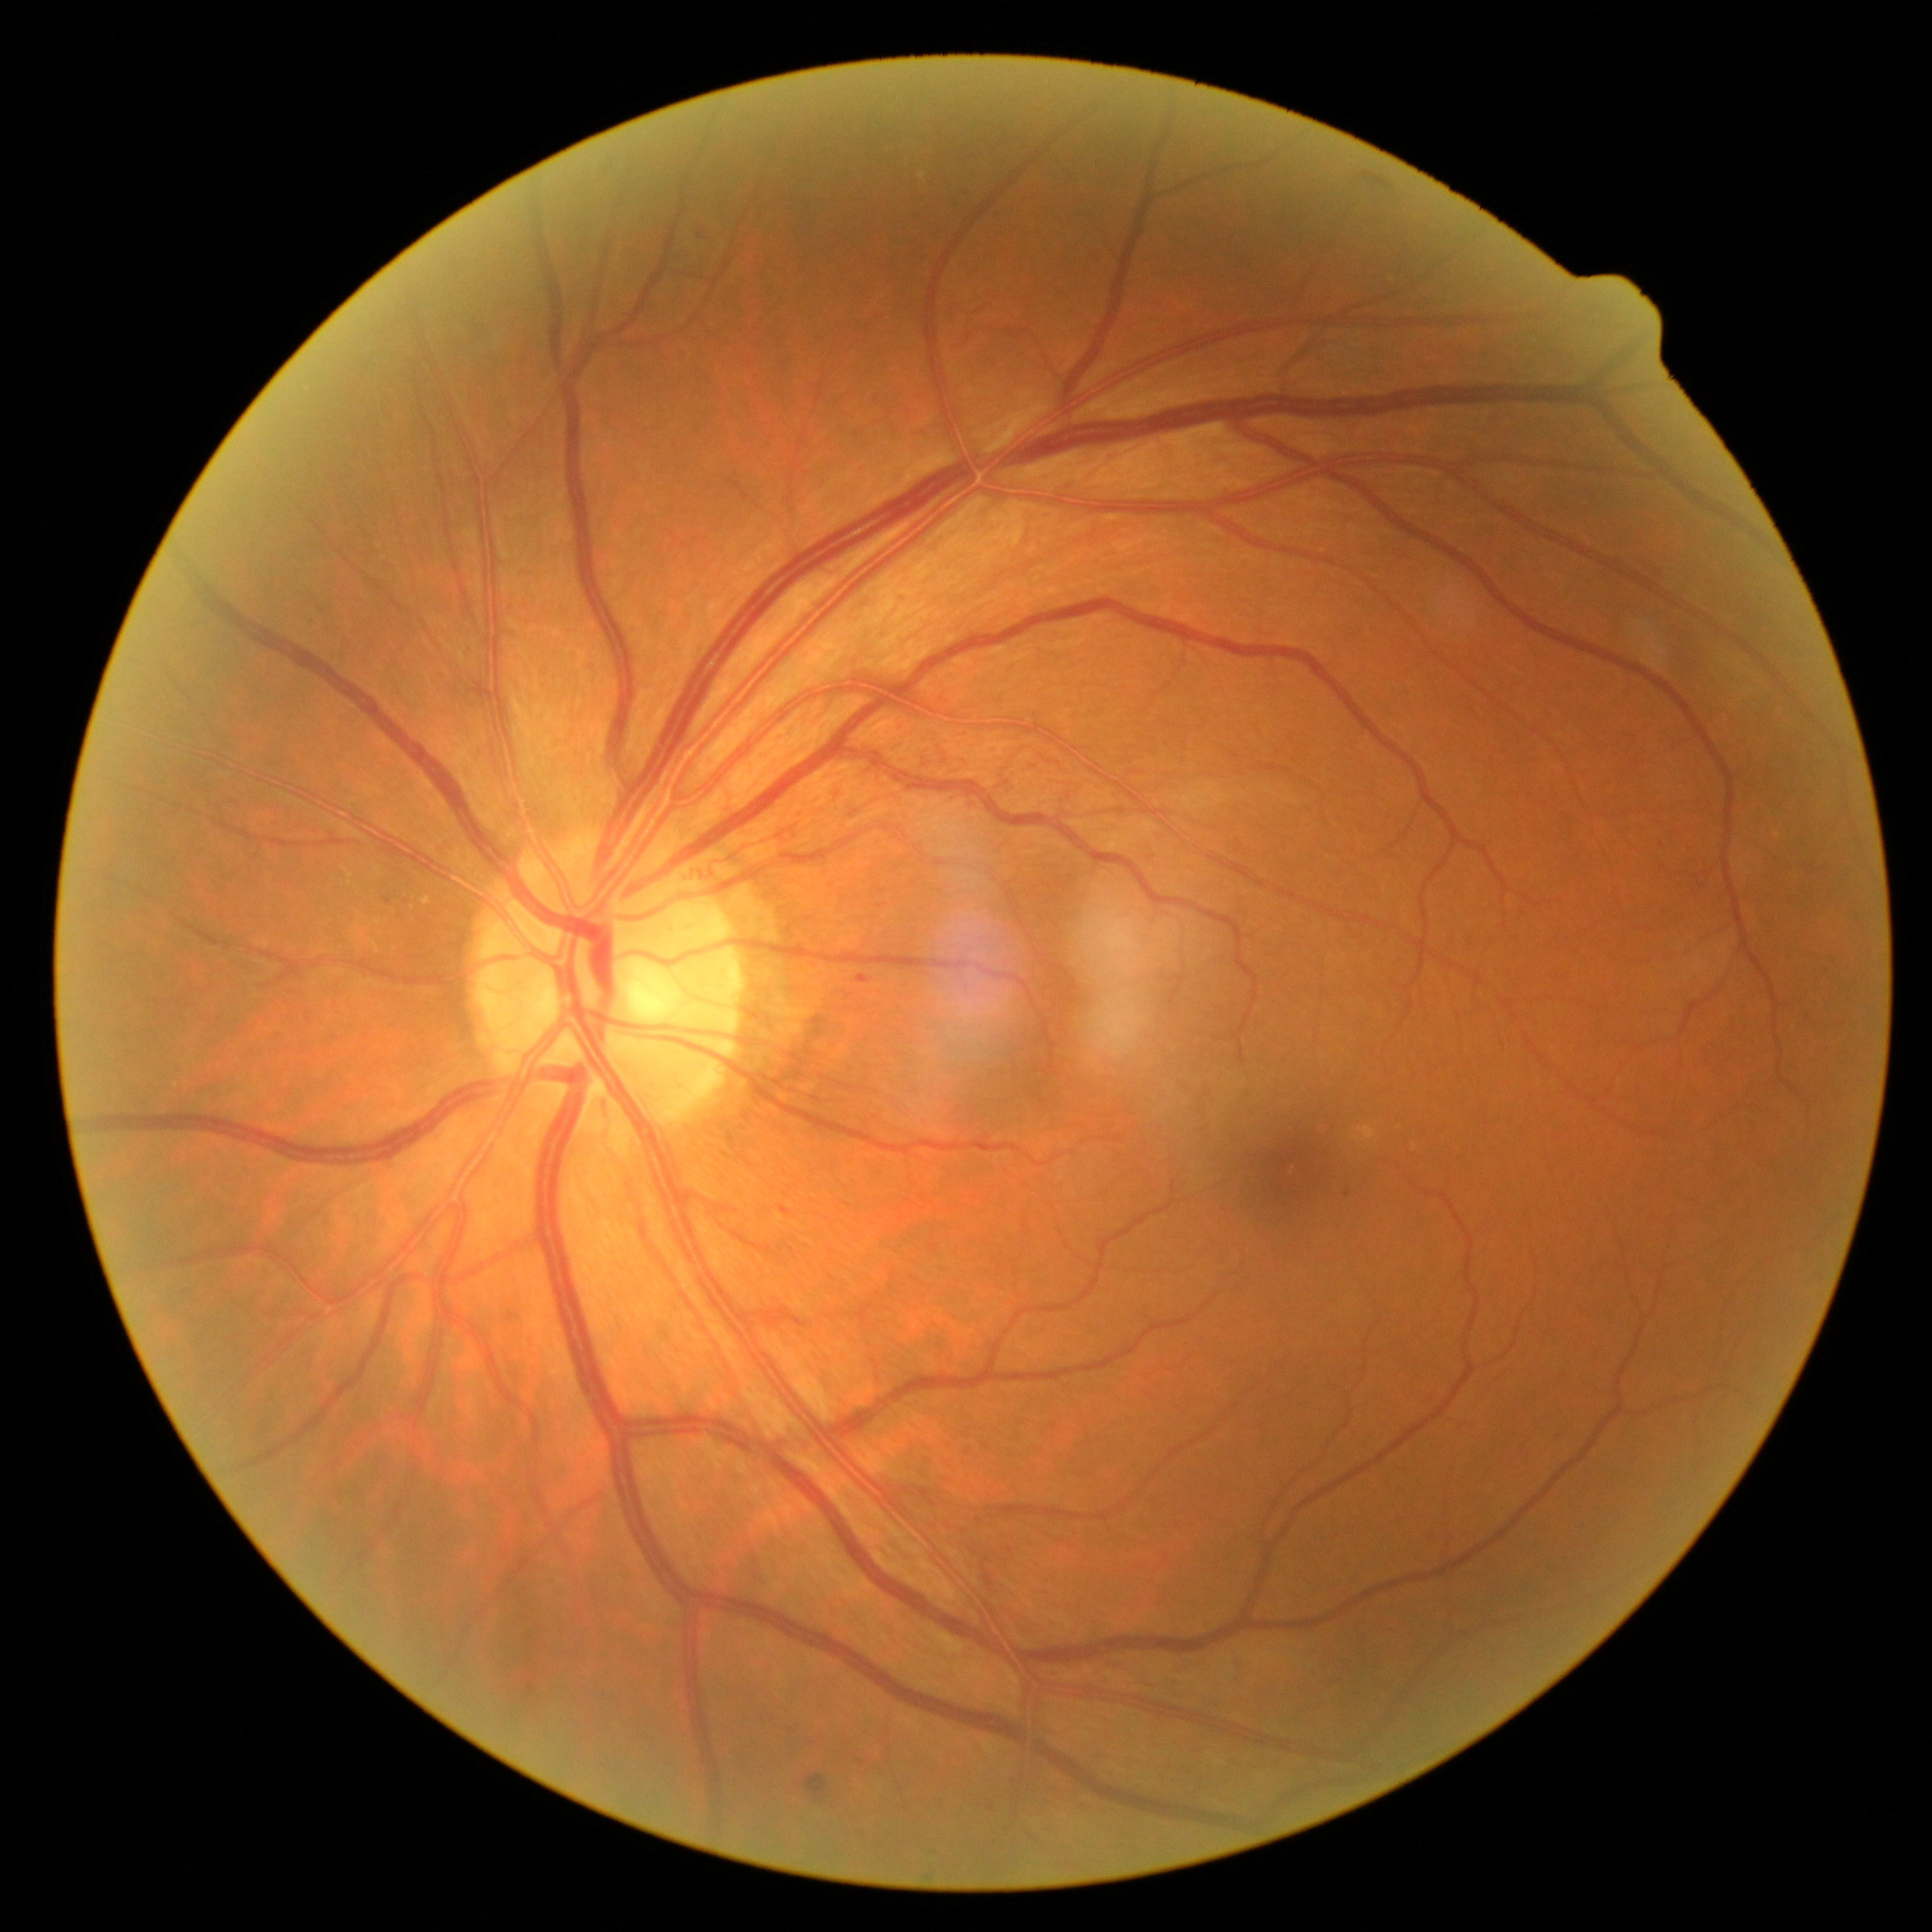

diabetic retinopathy = grade 2 (moderate NPDR)
DR class = non-proliferative diabetic retinopathy